1240 by 1240 pixels · wide-field fundus image from infant ROP screening — 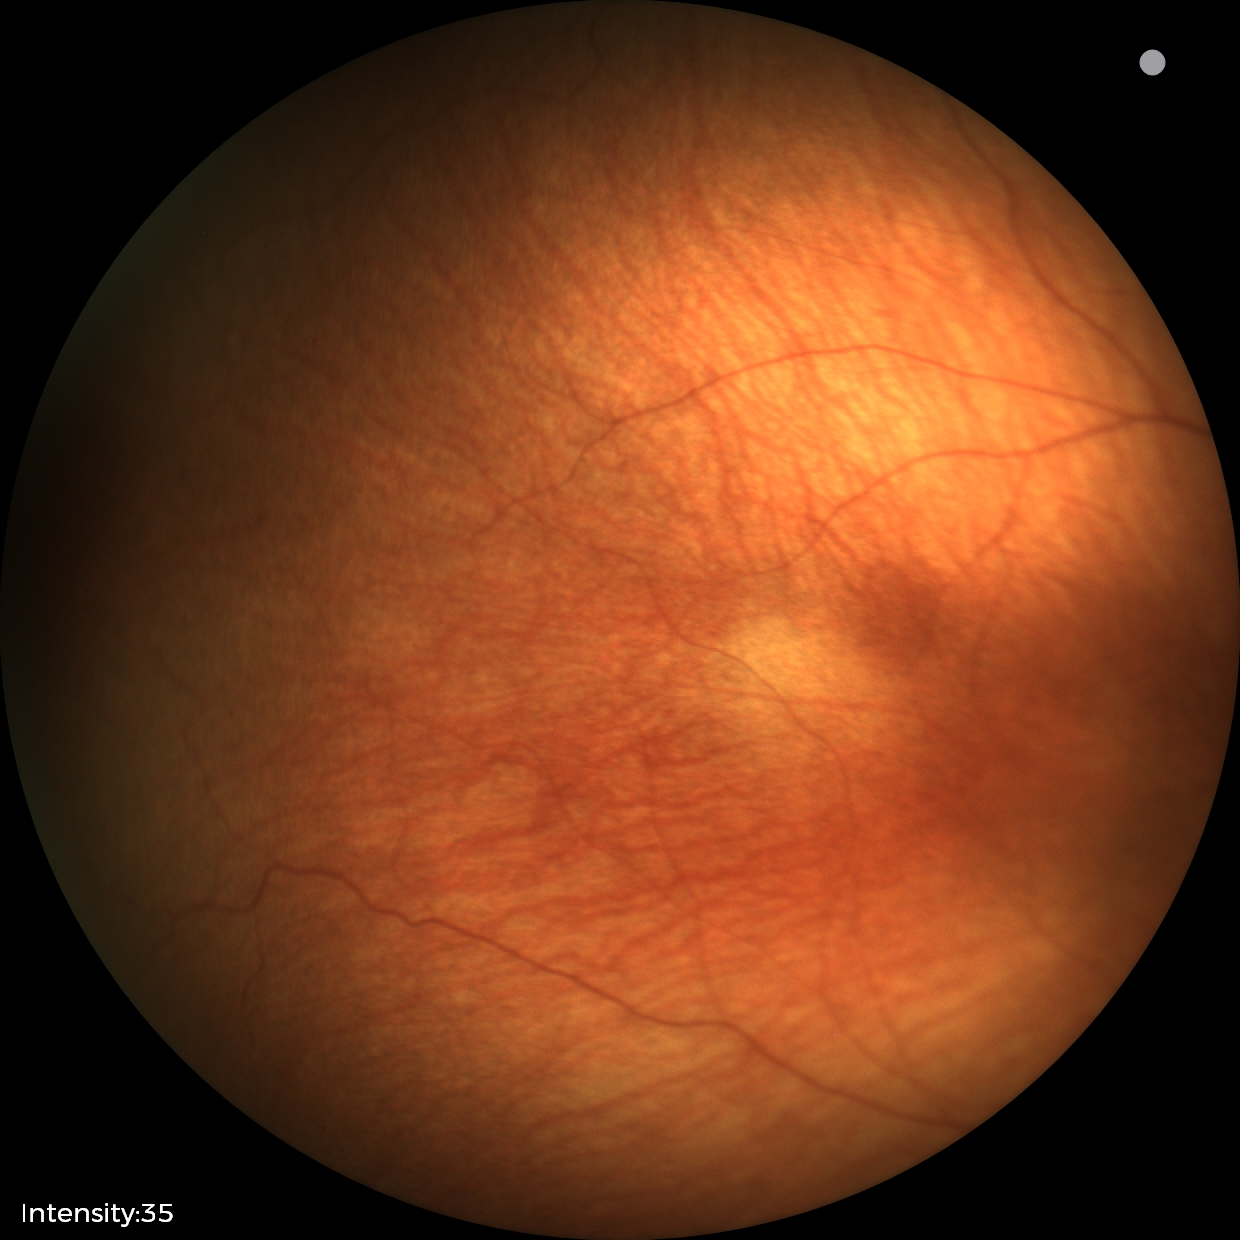 Plus form = absent, impression = status post retinopathy of prematurity.